Modified Davis grading · no pharmacologic dilation · 45° FOV: 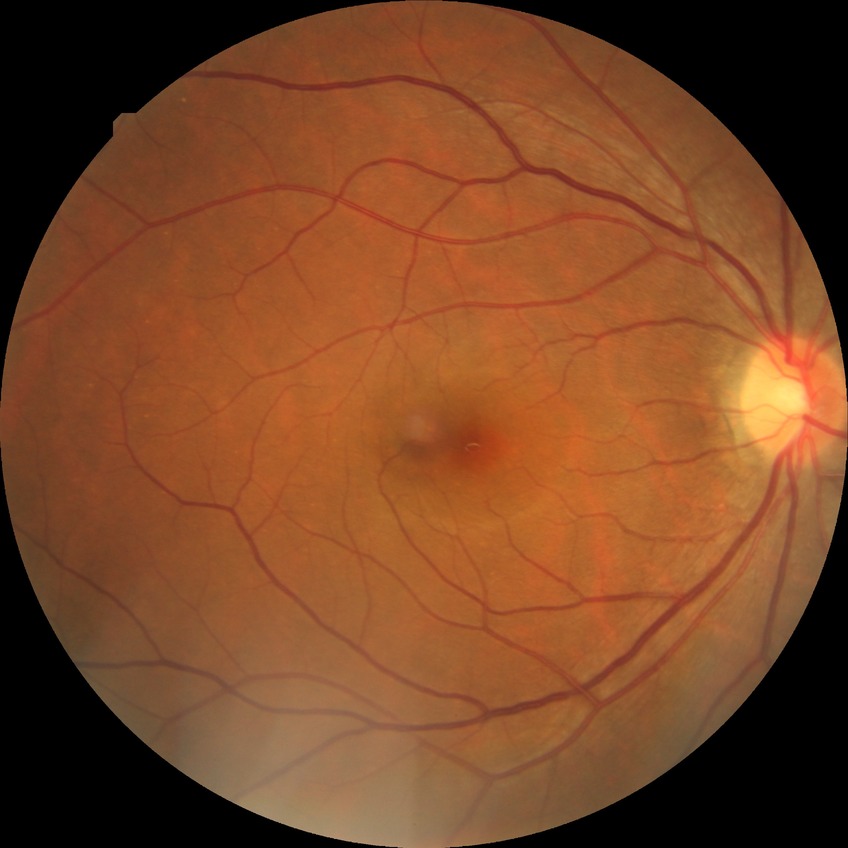
retinopathy grade@no diabetic retinopathy.